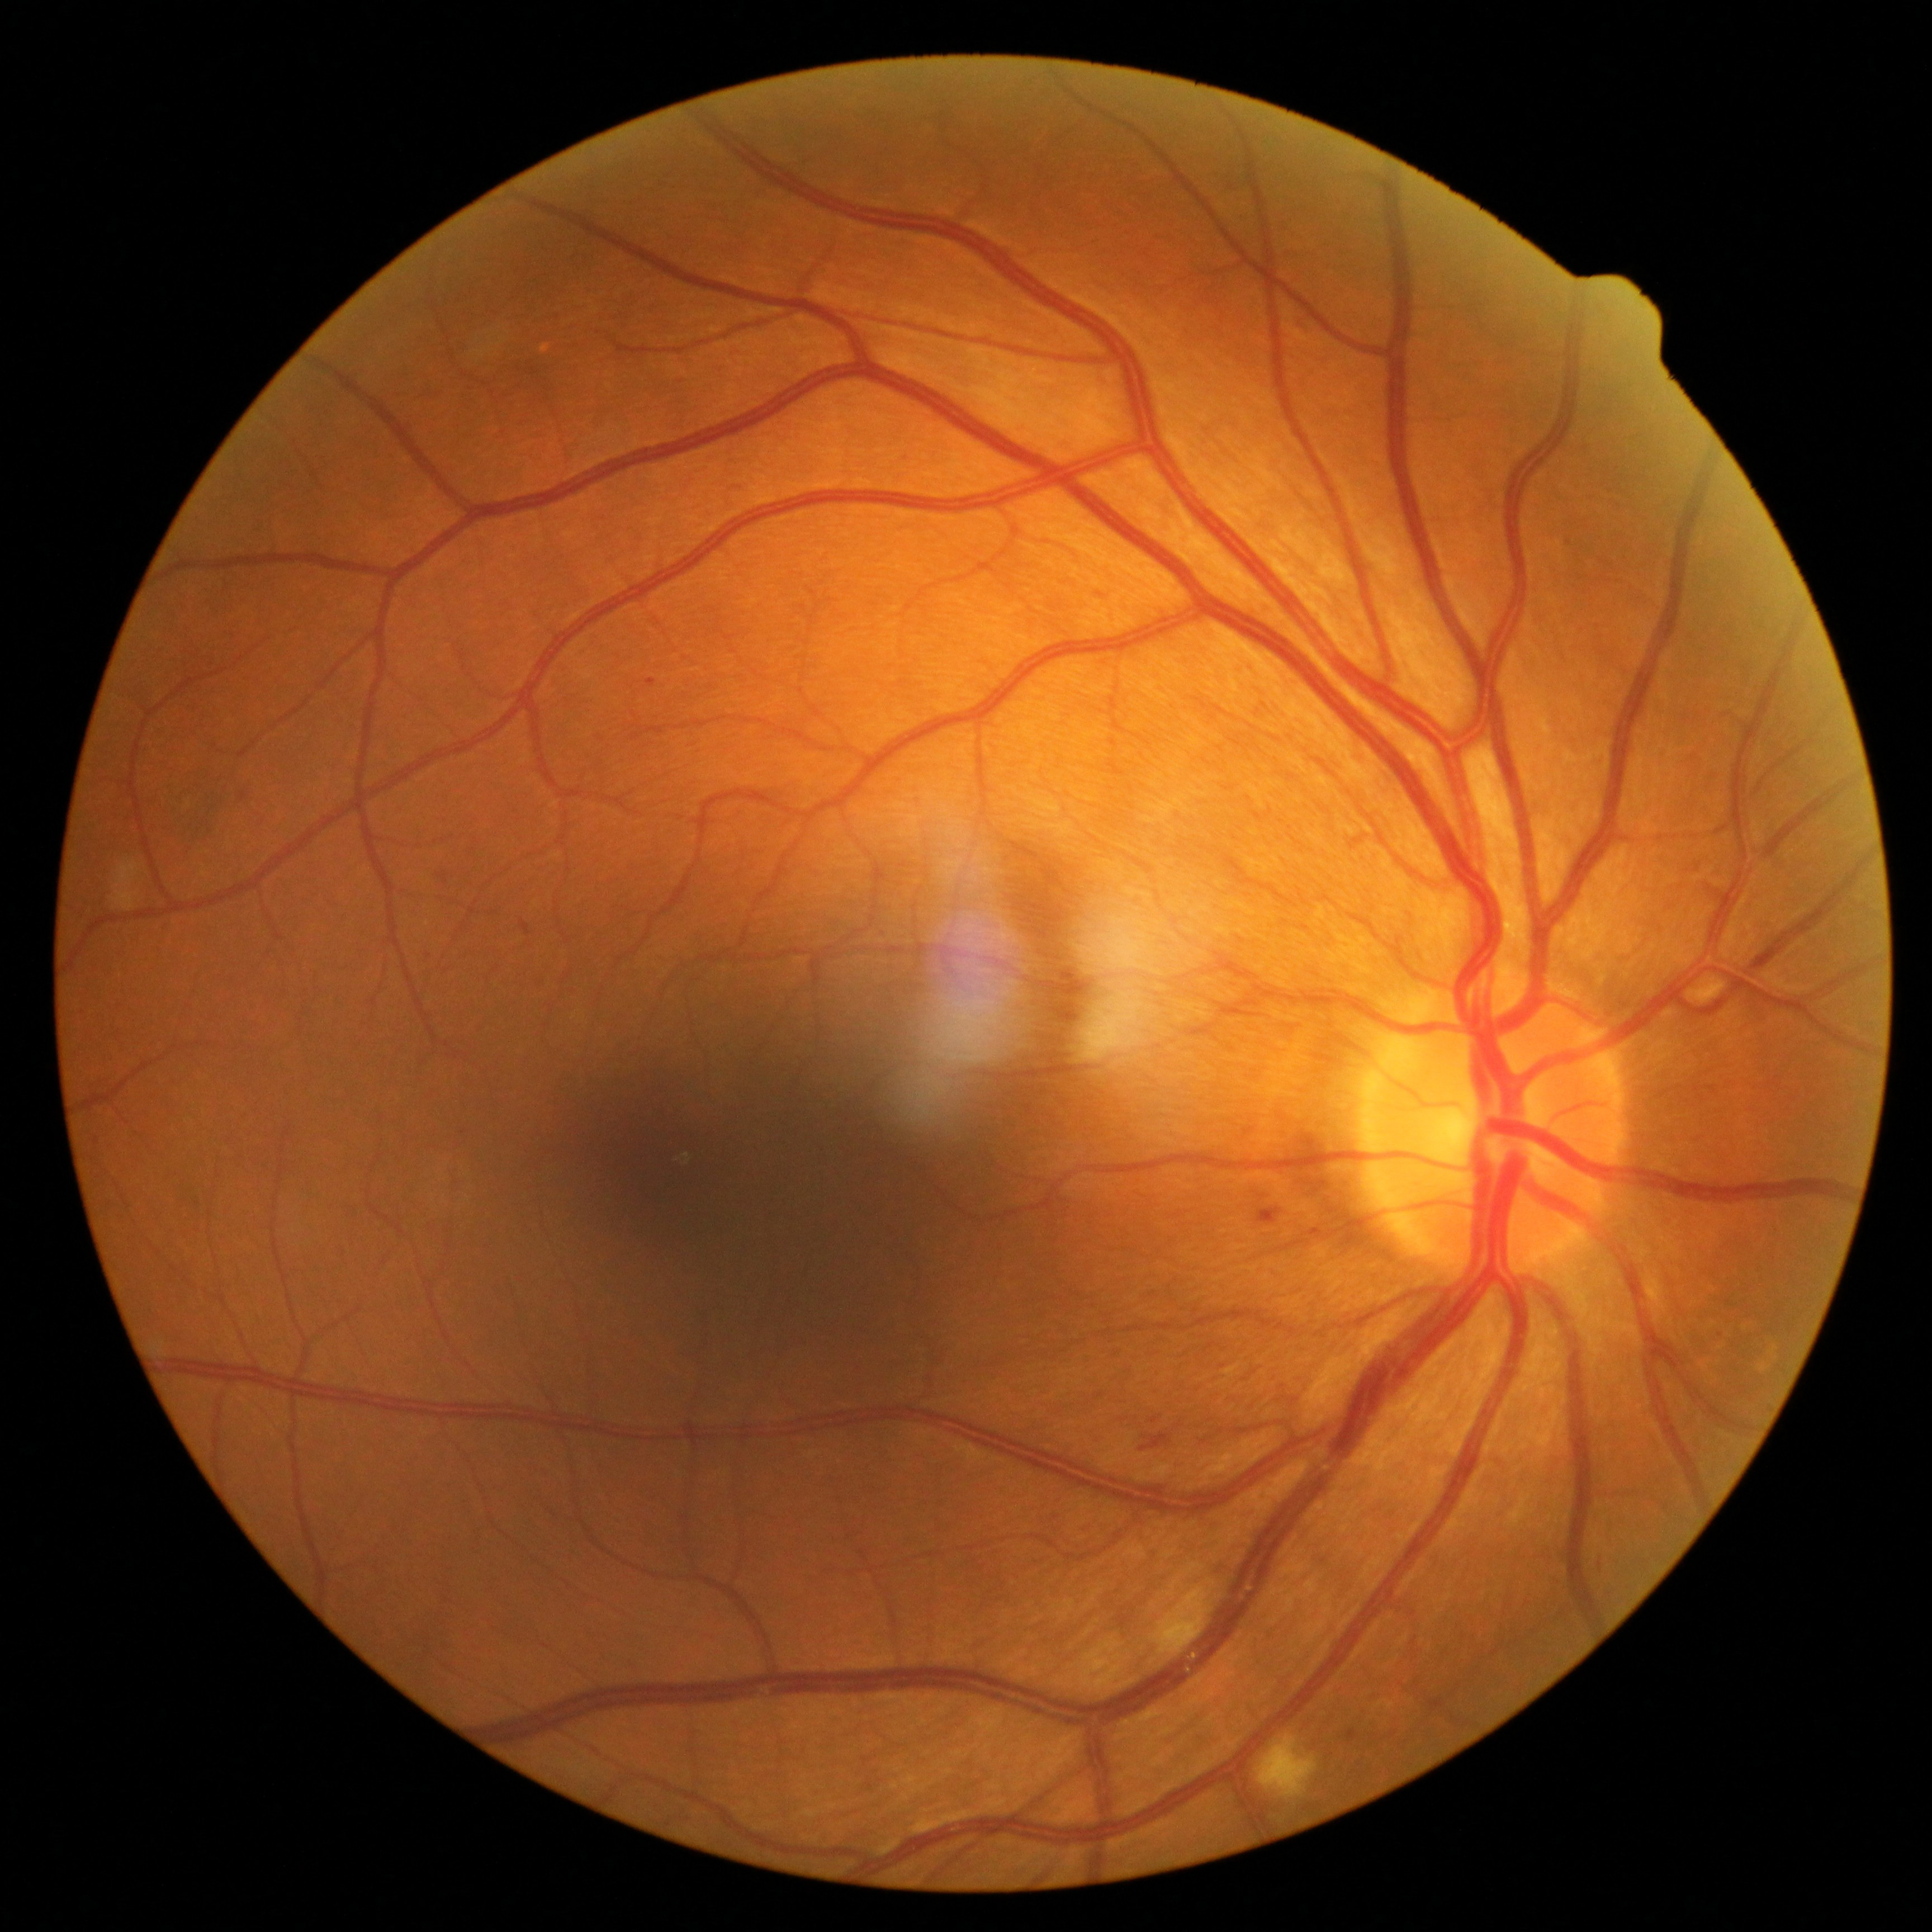
DR grade is moderate NPDR (2)
MAs = box=[519, 921, 531, 936]; box=[1298, 315, 1306, 324]; box=[1564, 534, 1573, 546]; box=[647, 679, 656, 688]; box=[1256, 1208, 1283, 1226]; box=[1580, 446, 1589, 457]; box=[1060, 1001, 1078, 1010]; box=[241, 793, 247, 802]; box=[1311, 1229, 1323, 1238]; box=[725, 484, 743, 496]; box=[1096, 592, 1104, 596]; box=[1064, 969, 1073, 978]; box=[1348, 1731, 1357, 1741]
EXs = none
HEs = box=[1598, 1557, 1607, 1575]; box=[1141, 1433, 1170, 1451]; box=[439, 874, 448, 885]
SEs = box=[1256, 1735, 1320, 1800]; box=[1149, 1585, 1214, 1655]